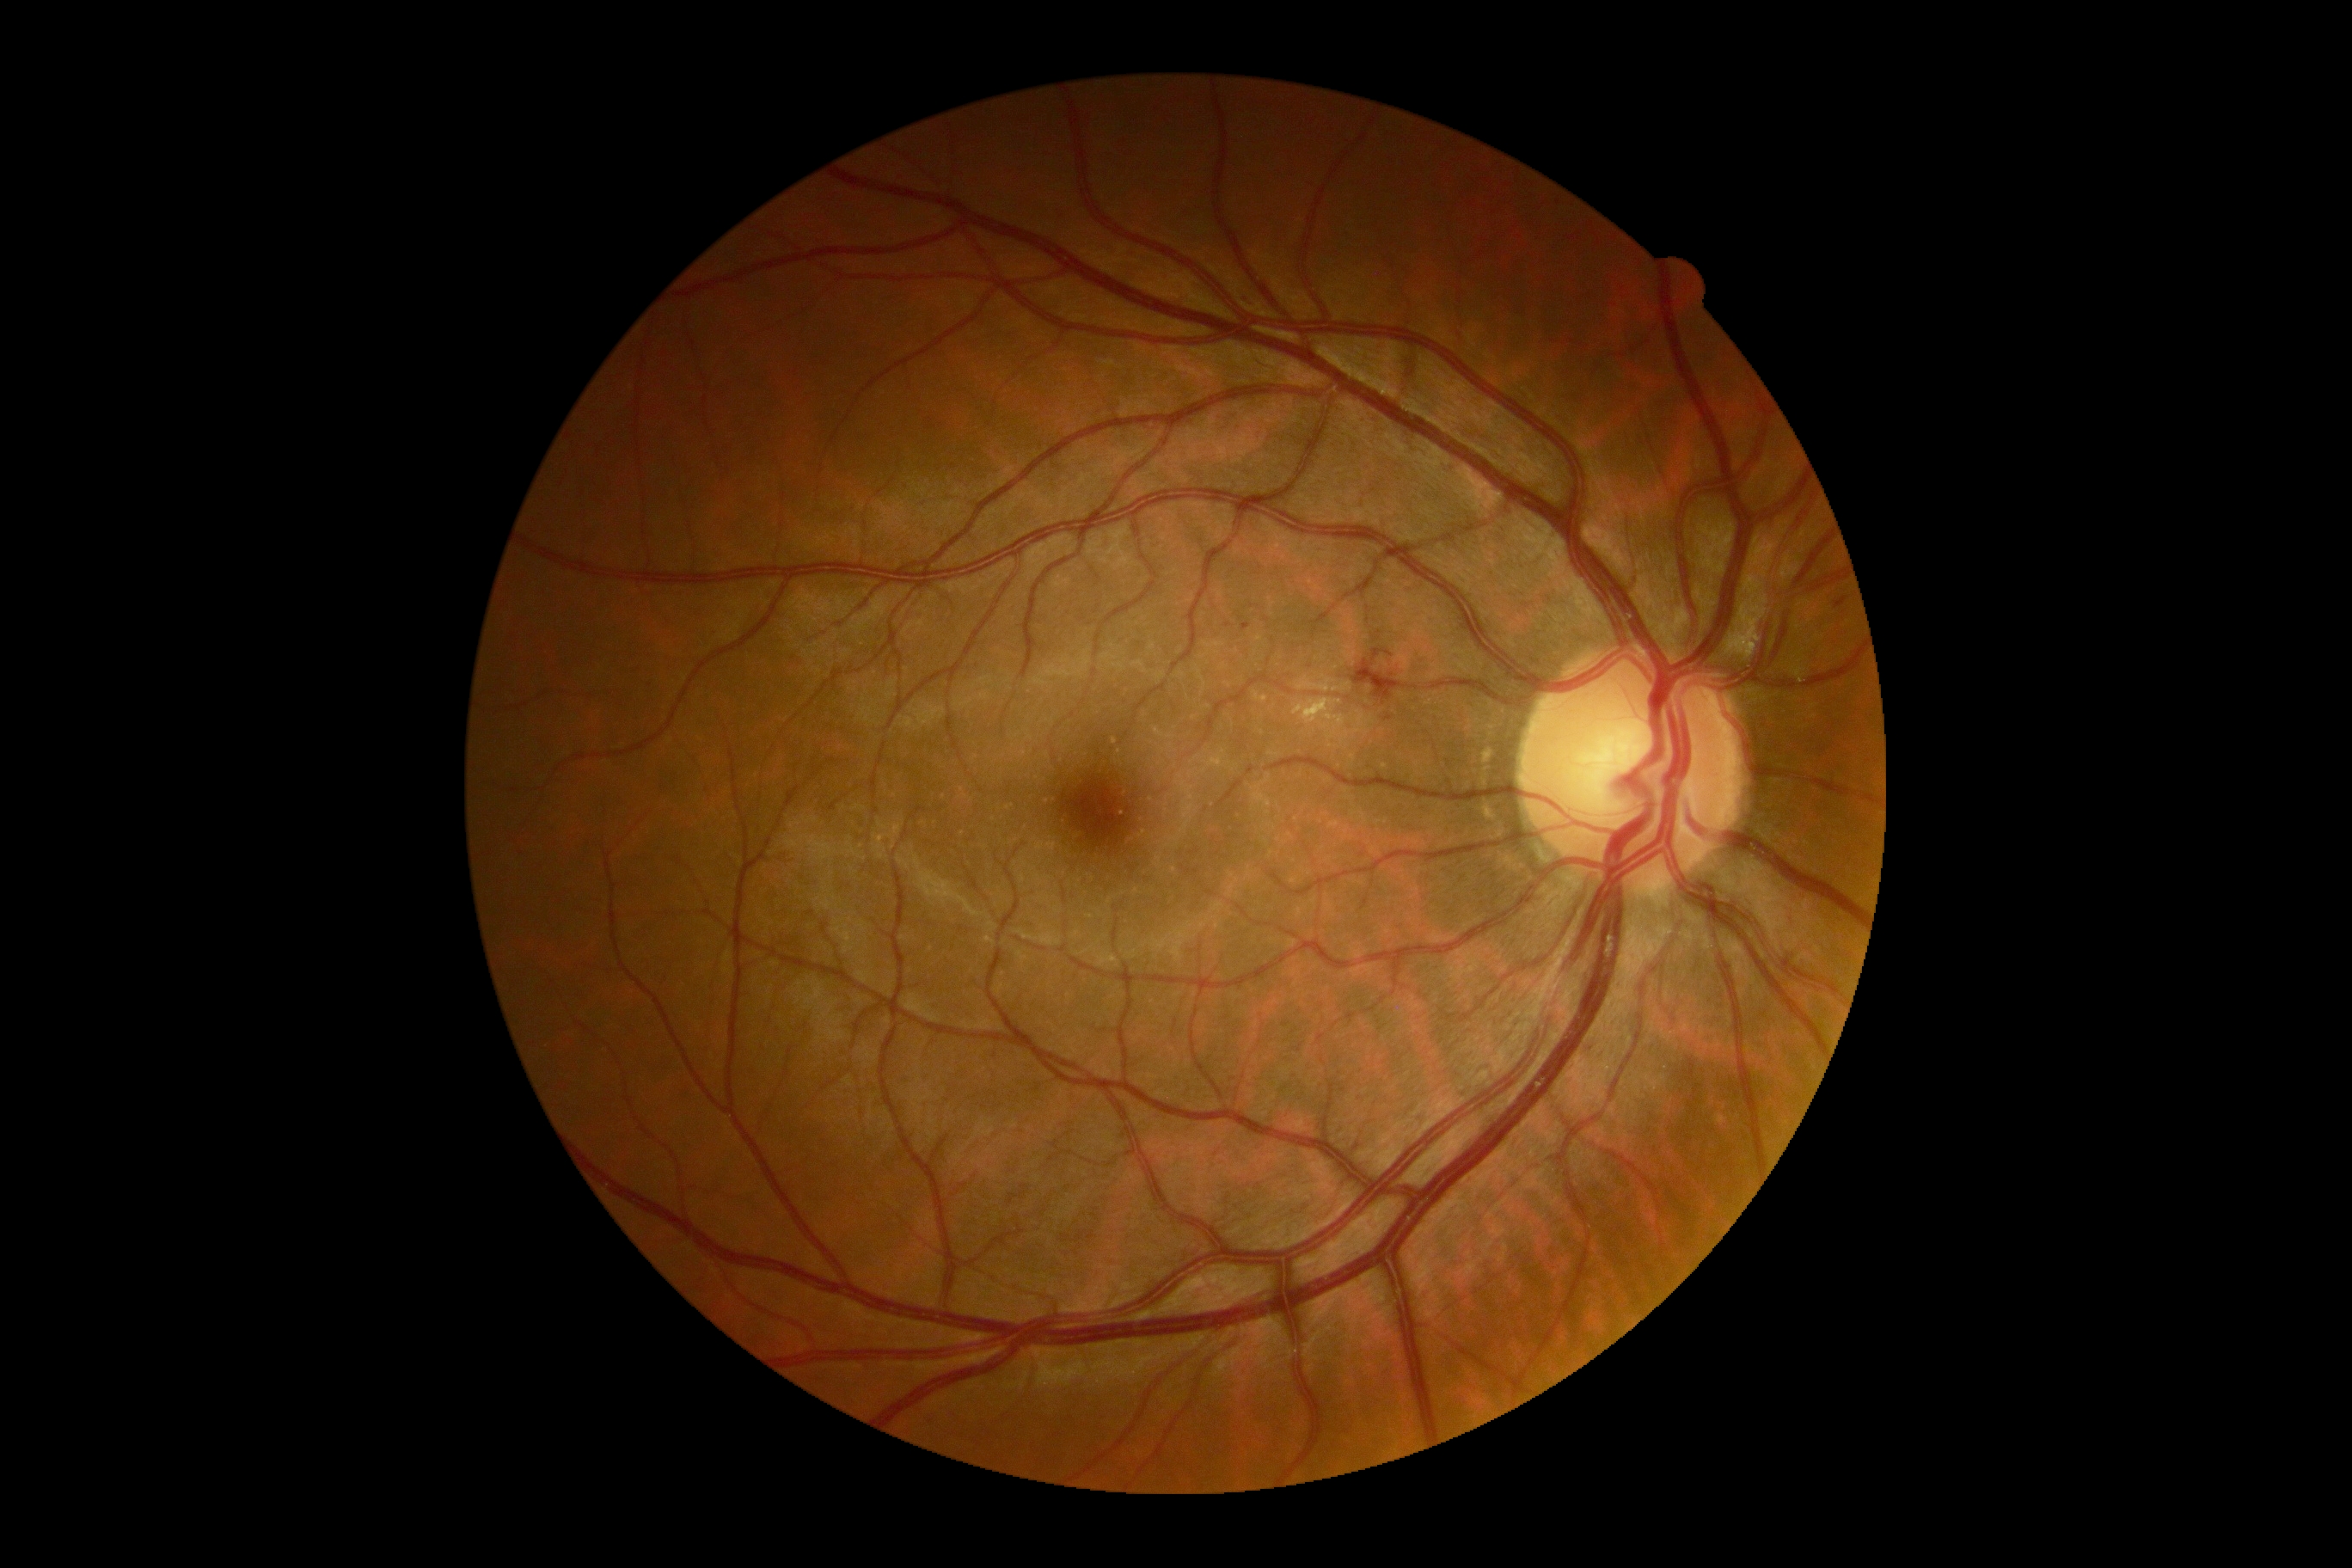

DR severity: moderate non-proliferative diabetic retinopathy (grade 2).